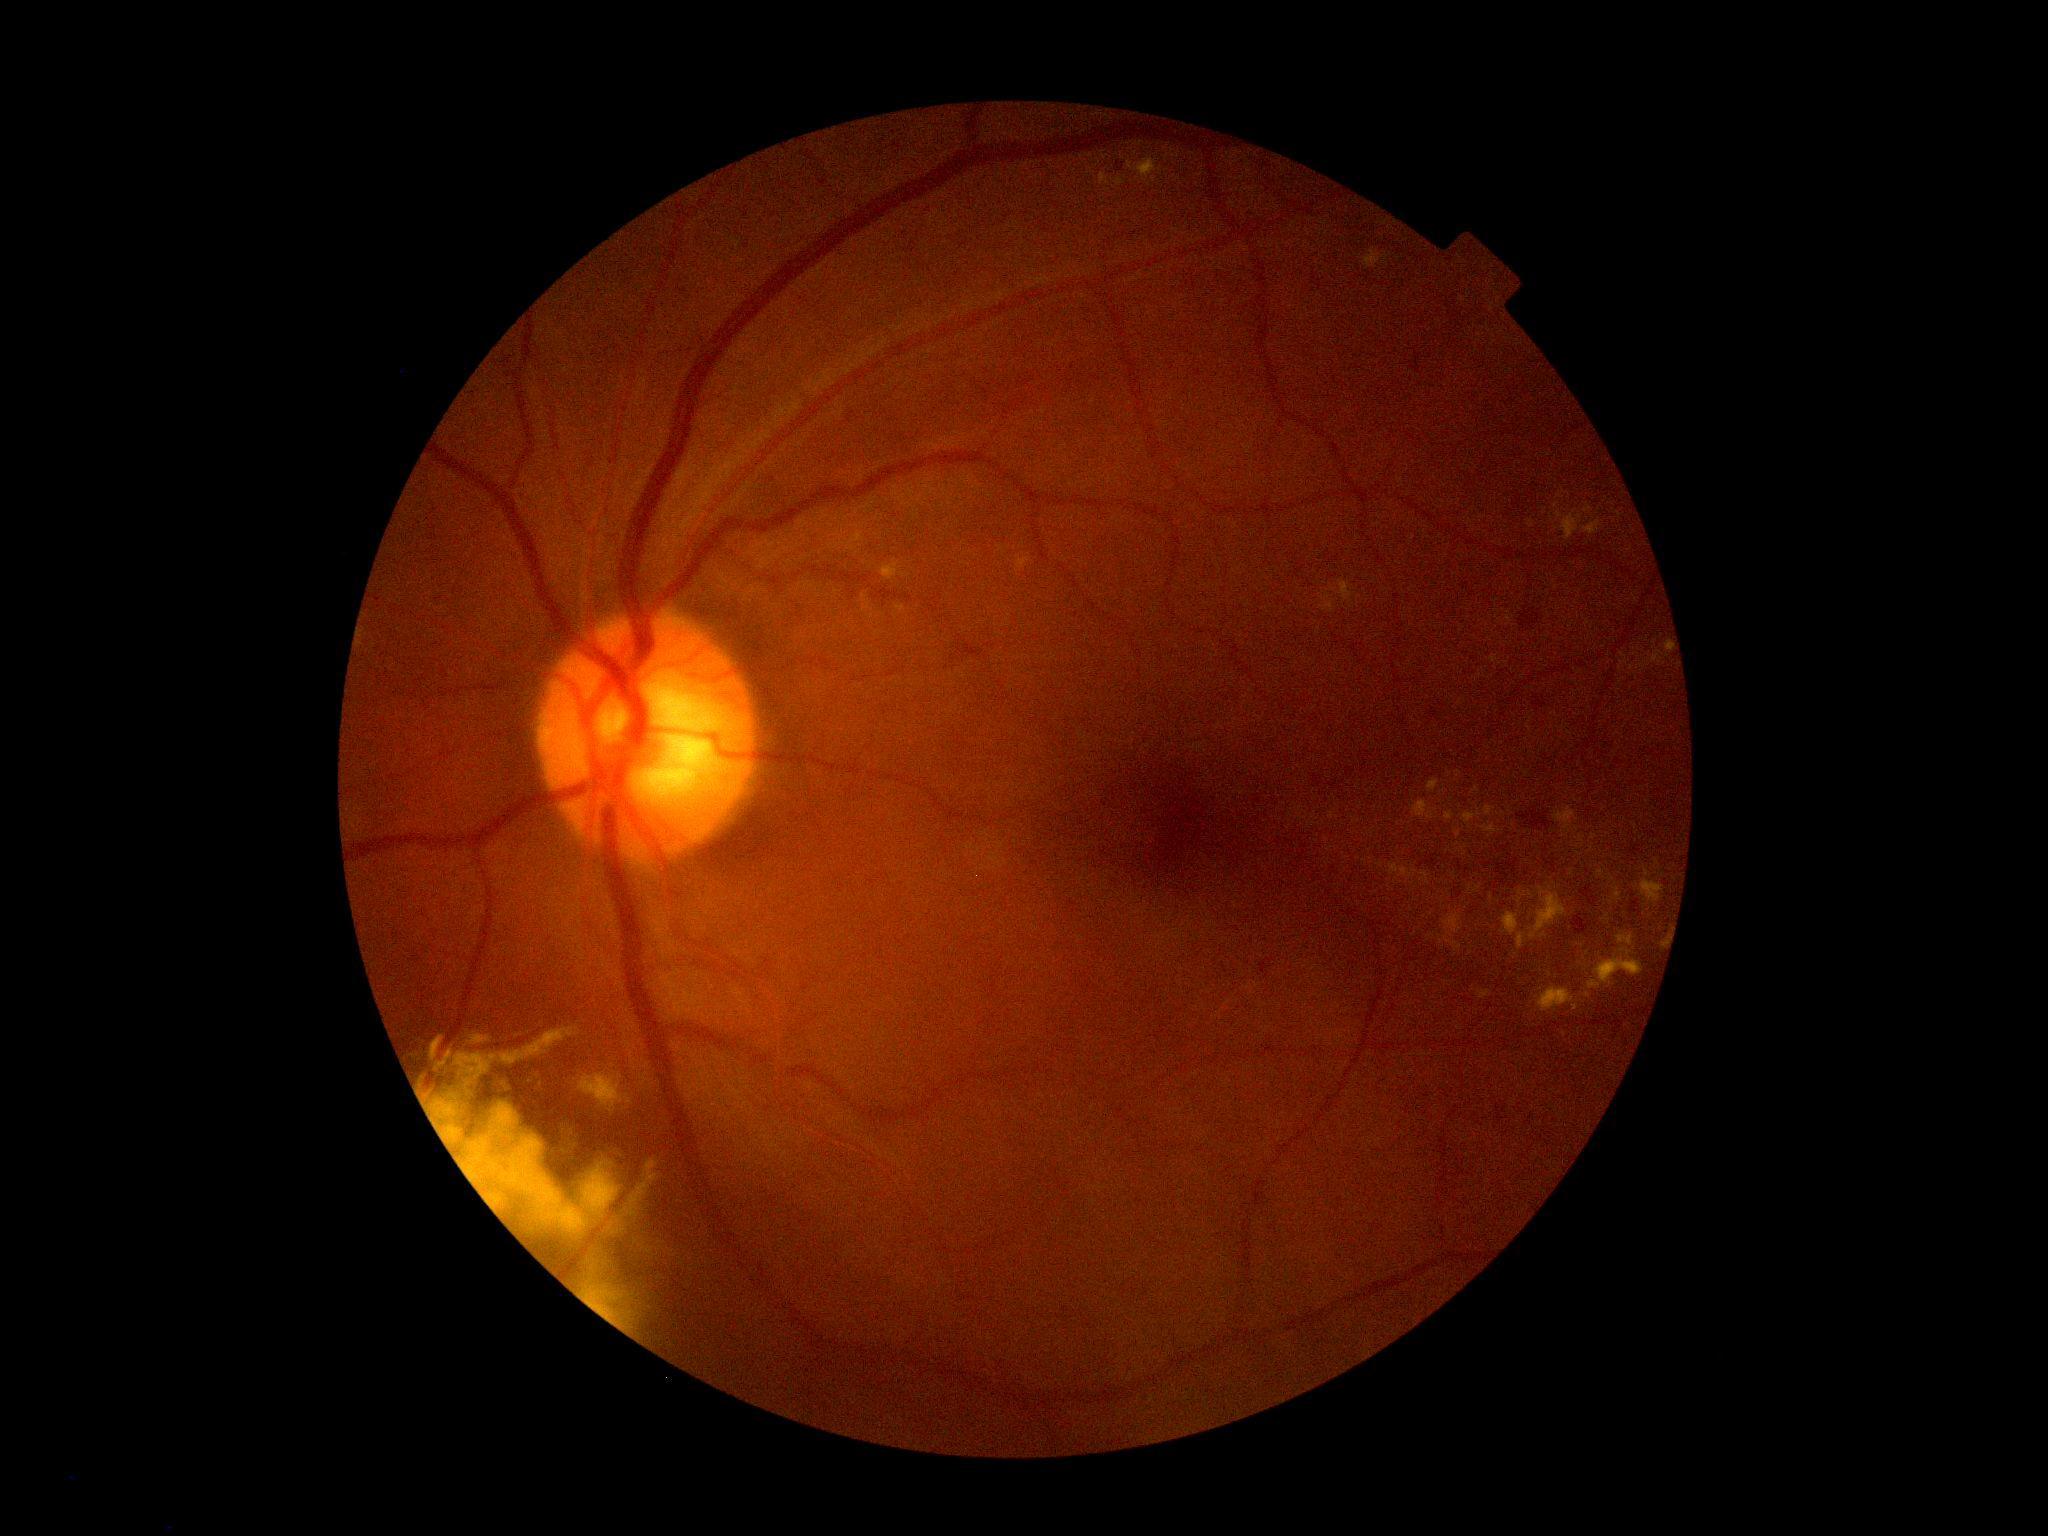 Diabetic retinopathy (DR): grade 2 (moderate NPDR) — more than just microaneurysms but less than severe NPDR.
Hard exudates (EXs) include lesions at 1529/887/1566/941 | 1578/835/1584/844 | 1539/934/1547/938 | 862/594/872/613 | 1420/871/1431/885 | 1502/912/1519/936 | 1128/158/1163/182 | 880/560/911/581 | 1518/891/1535/908 | 1445/811/1454/821.
Smaller EXs around <point>1445, 792</point> | <point>1476, 790</point> | <point>1491, 898</point> | <point>1466, 853</point> | <point>623, 1322</point> | <point>1407, 996</point>.